Wide-field contact fundus photograph of an infant: 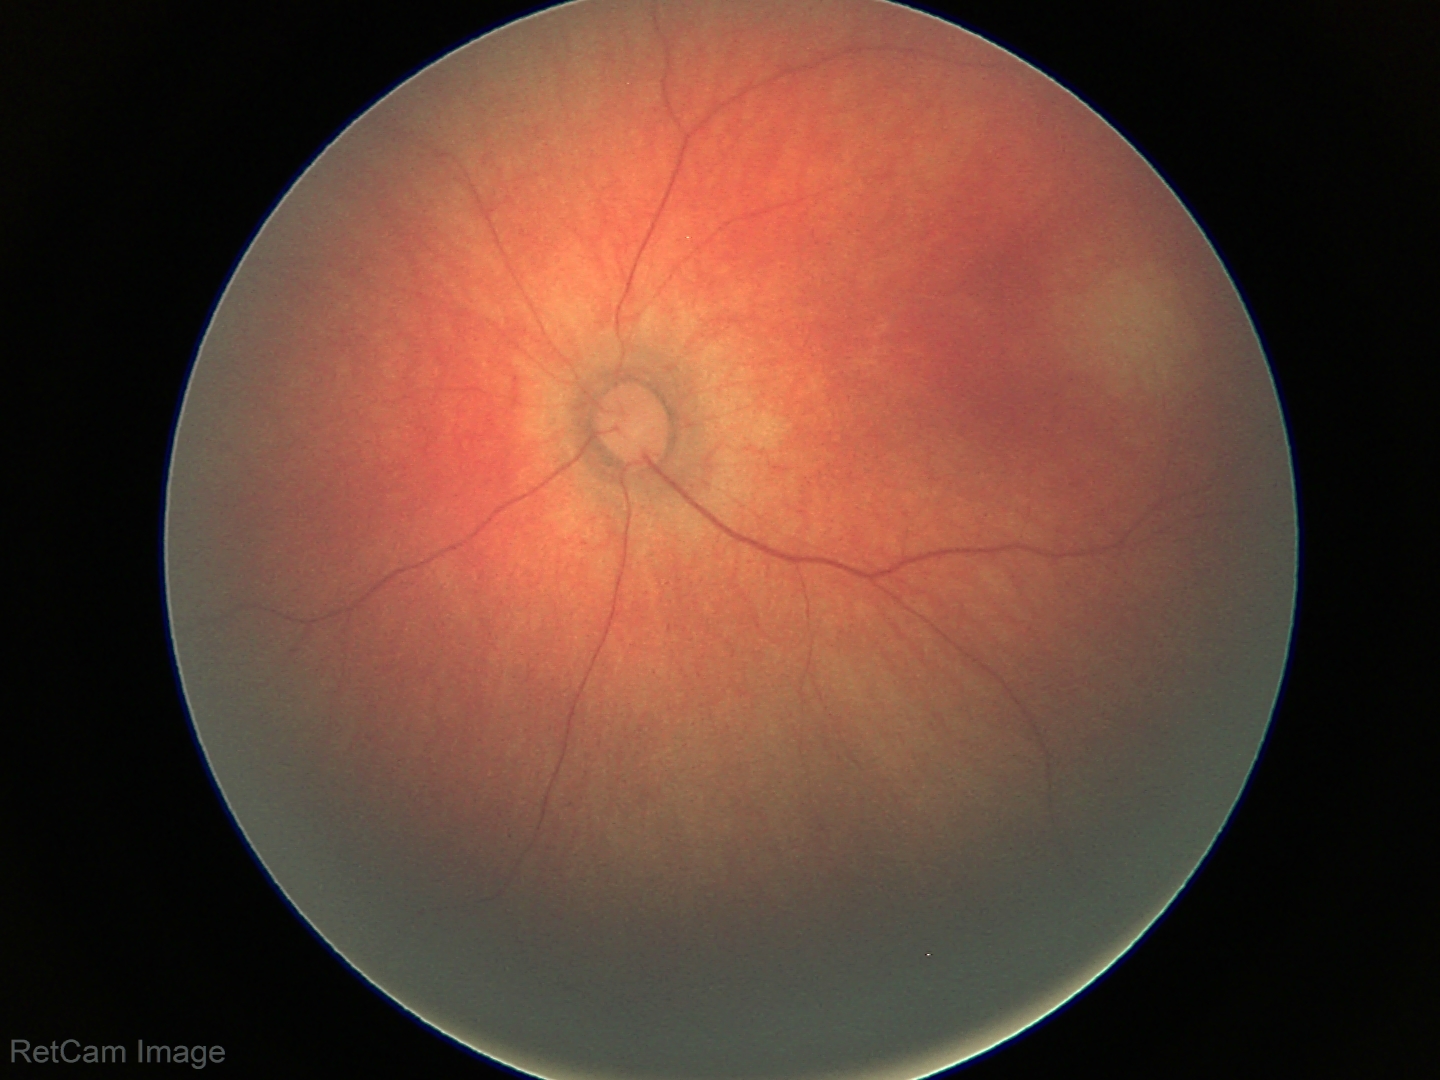 Diagnosis = normal.